NIDEK AFC-230 · retinal fundus photograph: 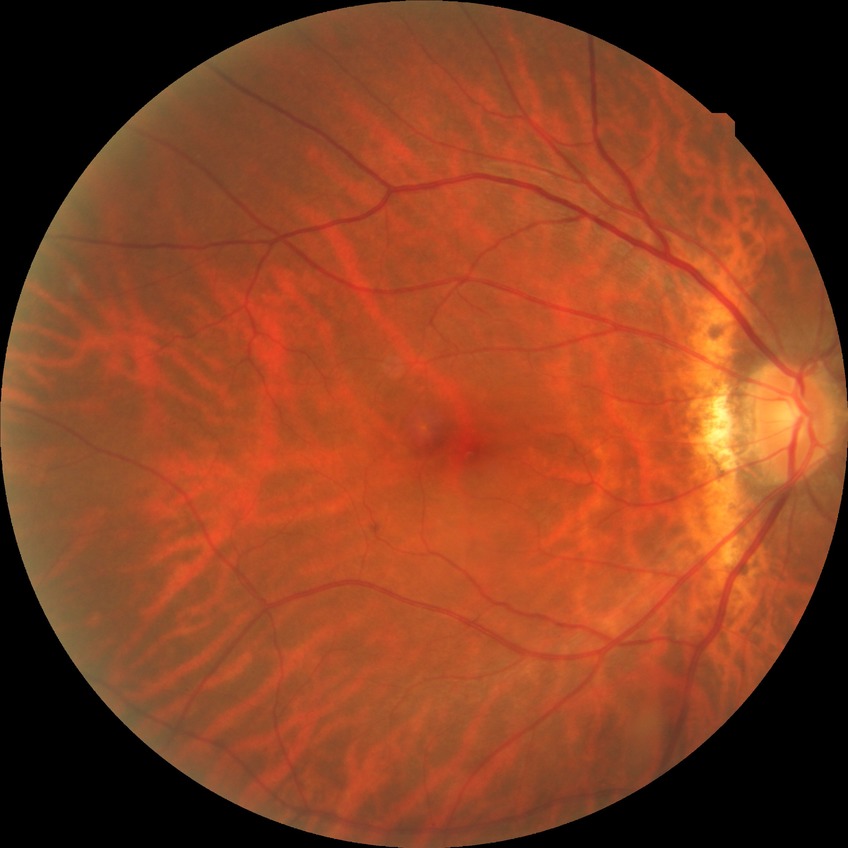 modified Davis grading: no diabetic retinopathy.